Color fundus image · 2352 by 1568 pixels.
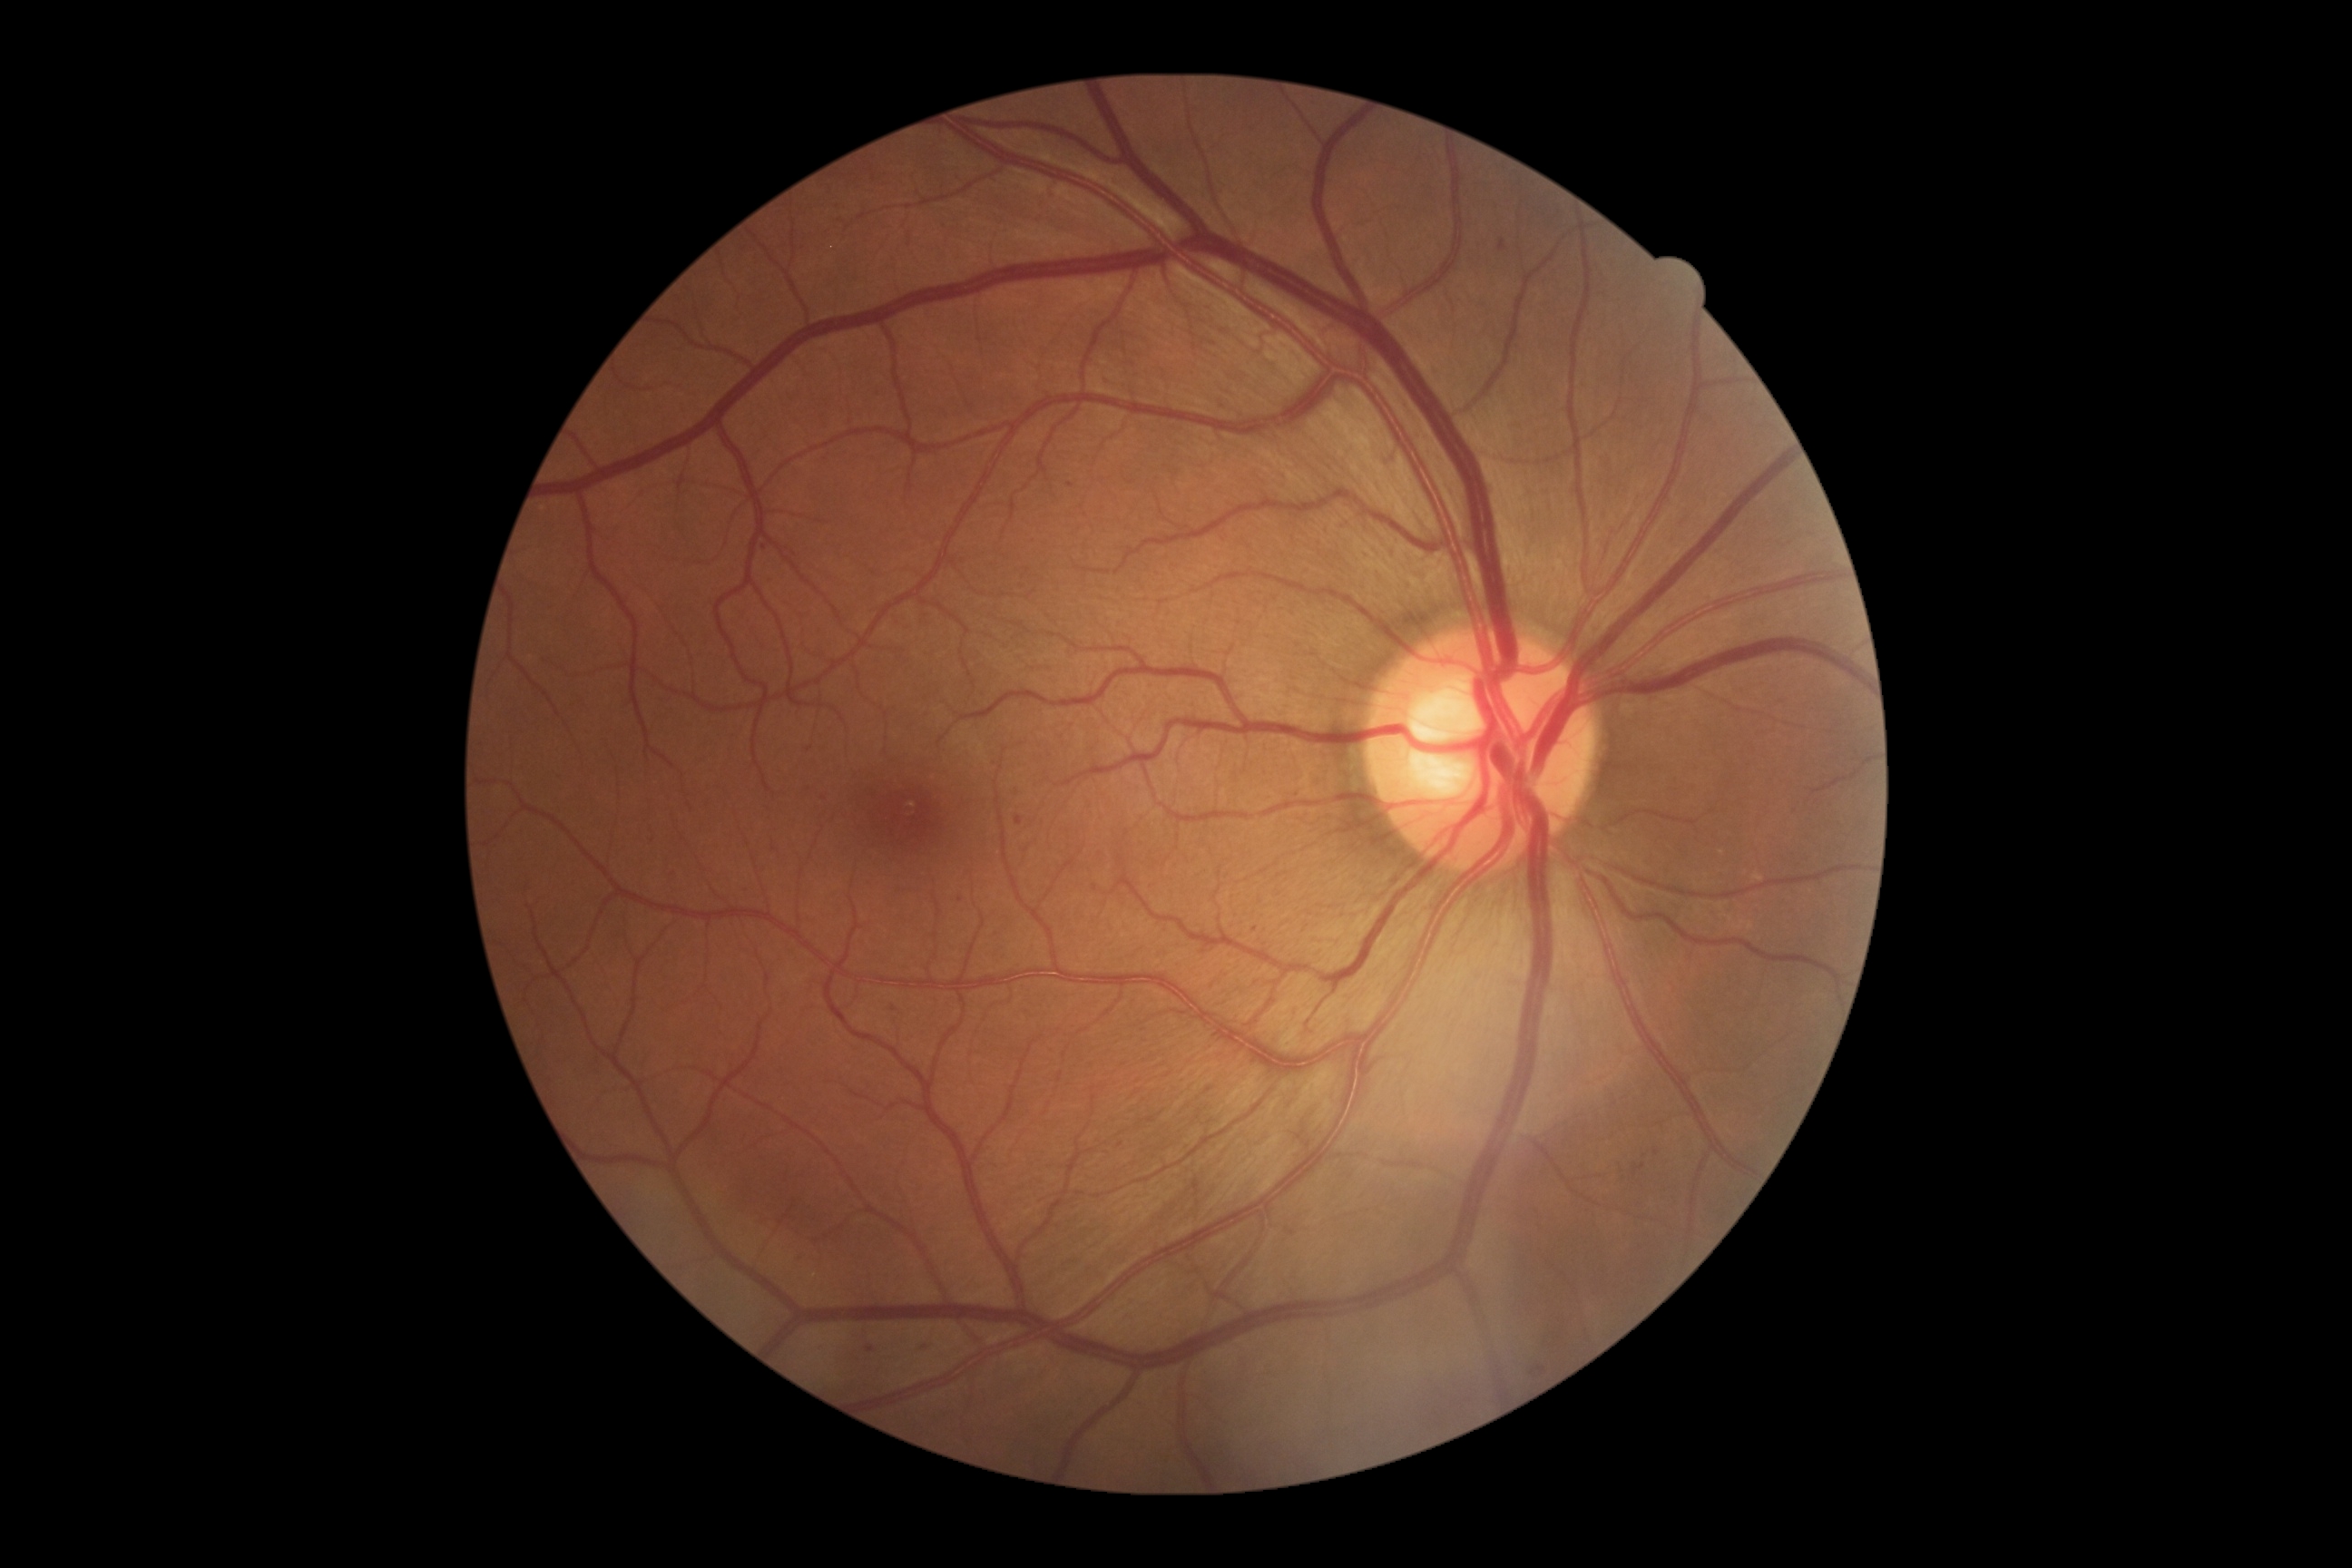

Diabetic retinopathy (DR) is grade 1.
No soft exudates (SEs) identified.
Microaneurysms (MAs) present at [left=1015, top=816, right=1023, bottom=825]; [left=1500, top=239, right=1507, bottom=251]; [left=867, top=1348, right=876, bottom=1353].
Additional small MAs near 1070:486; 1256:930; 961:901; 1640:1163; 764:548; 1657:1152; 825:797; 894:1010; 1120:1145; 922:1345; 804:1257.
No hemorrhages (HEs) identified.
No hard exudates (EXs) identified.